Image size 1380x1382, color fundus image: 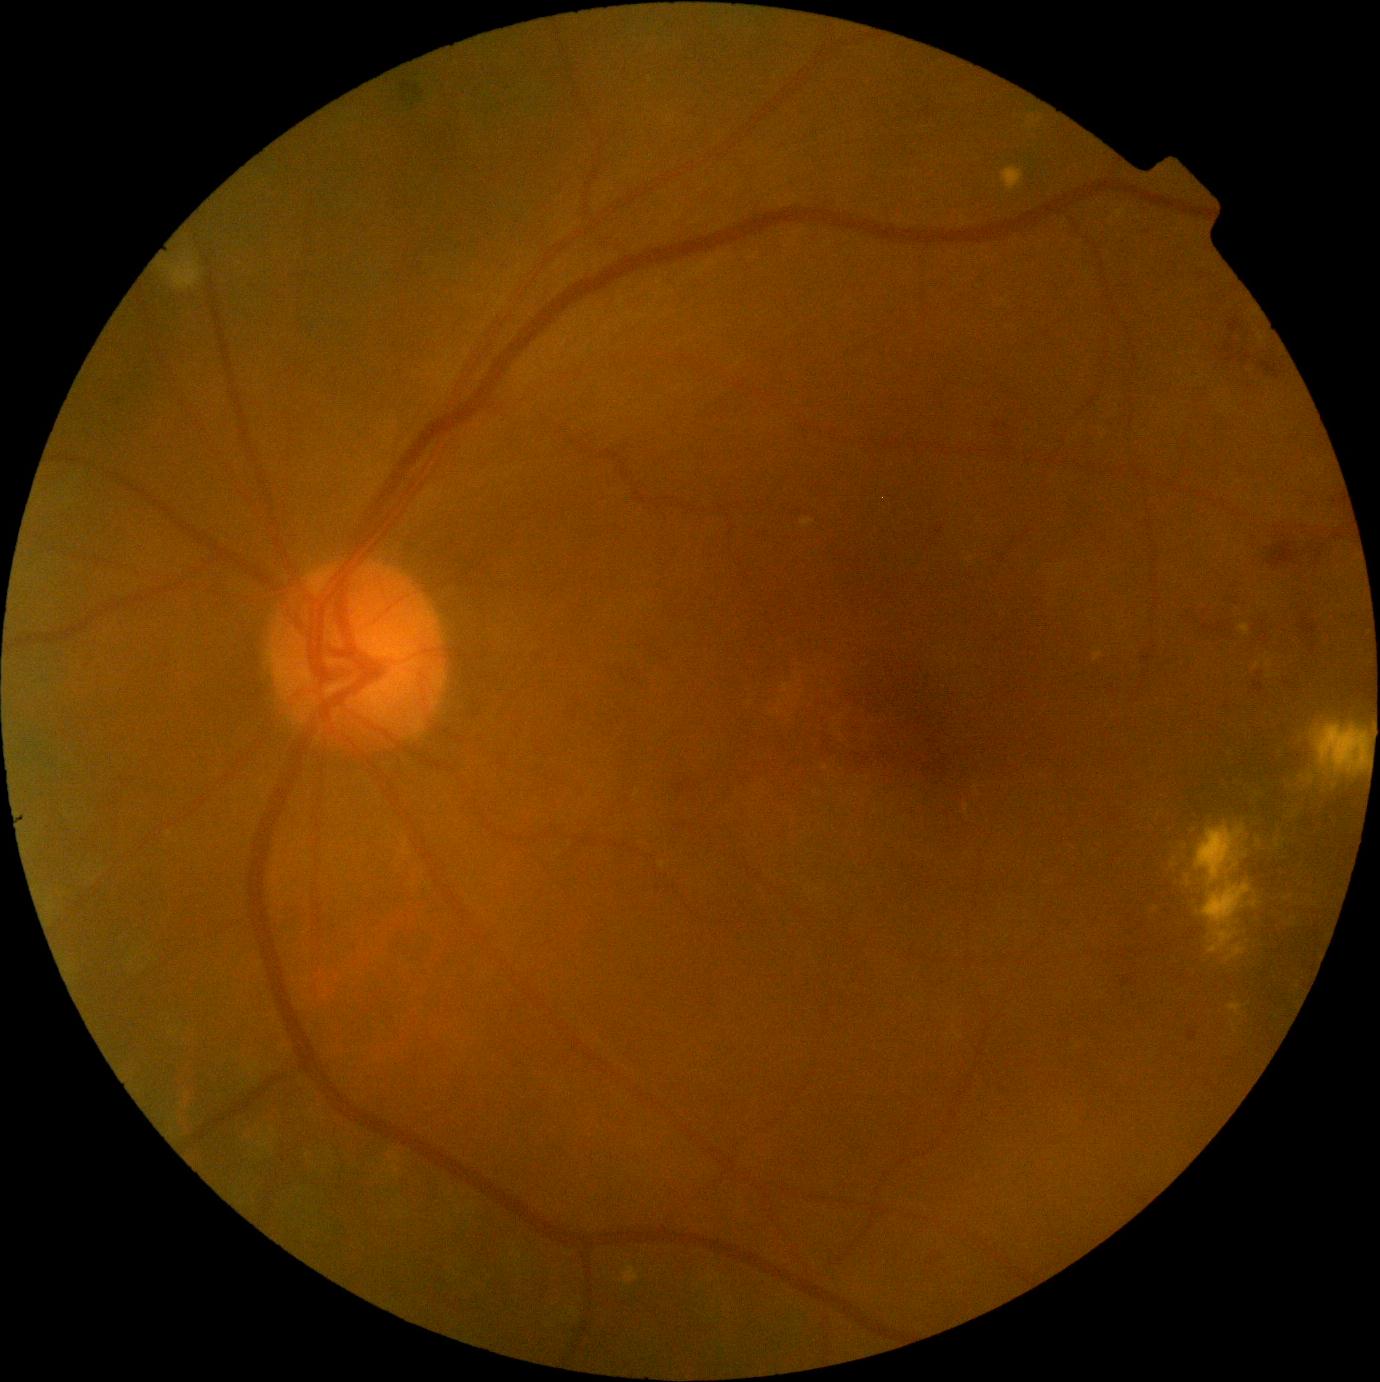
Diabetic retinopathy (DR): grade 2 (moderate NPDR)
hard exudates (EXs): box(1315, 725, 1369, 773), box(1227, 1004, 1245, 1017), box(1094, 651, 1103, 662), box(802, 518, 815, 529), box(1209, 930, 1238, 953), box(1226, 945, 1246, 962), box(622, 1263, 640, 1286), box(1002, 166, 1025, 192), box(1184, 876, 1194, 893), box(1203, 883, 1250, 930), box(1240, 624, 1250, 637), box(1196, 825, 1246, 886), box(1254, 662, 1261, 670)
Smaller EXs around <pt>1156,909</pt>
hemorrhages (HEs): box(1257, 615, 1273, 646), box(998, 549, 1008, 564), box(669, 779, 692, 792), box(1262, 363, 1280, 379), box(934, 527, 946, 537), box(1229, 319, 1244, 333), box(1266, 542, 1295, 568), box(1254, 682, 1264, 693), box(1206, 624, 1237, 643), box(1225, 344, 1235, 354), box(1299, 618, 1316, 635), box(993, 428, 1006, 440)
microaneurysms (MAs): none
soft exudates (SEs): box(167, 263, 200, 290)